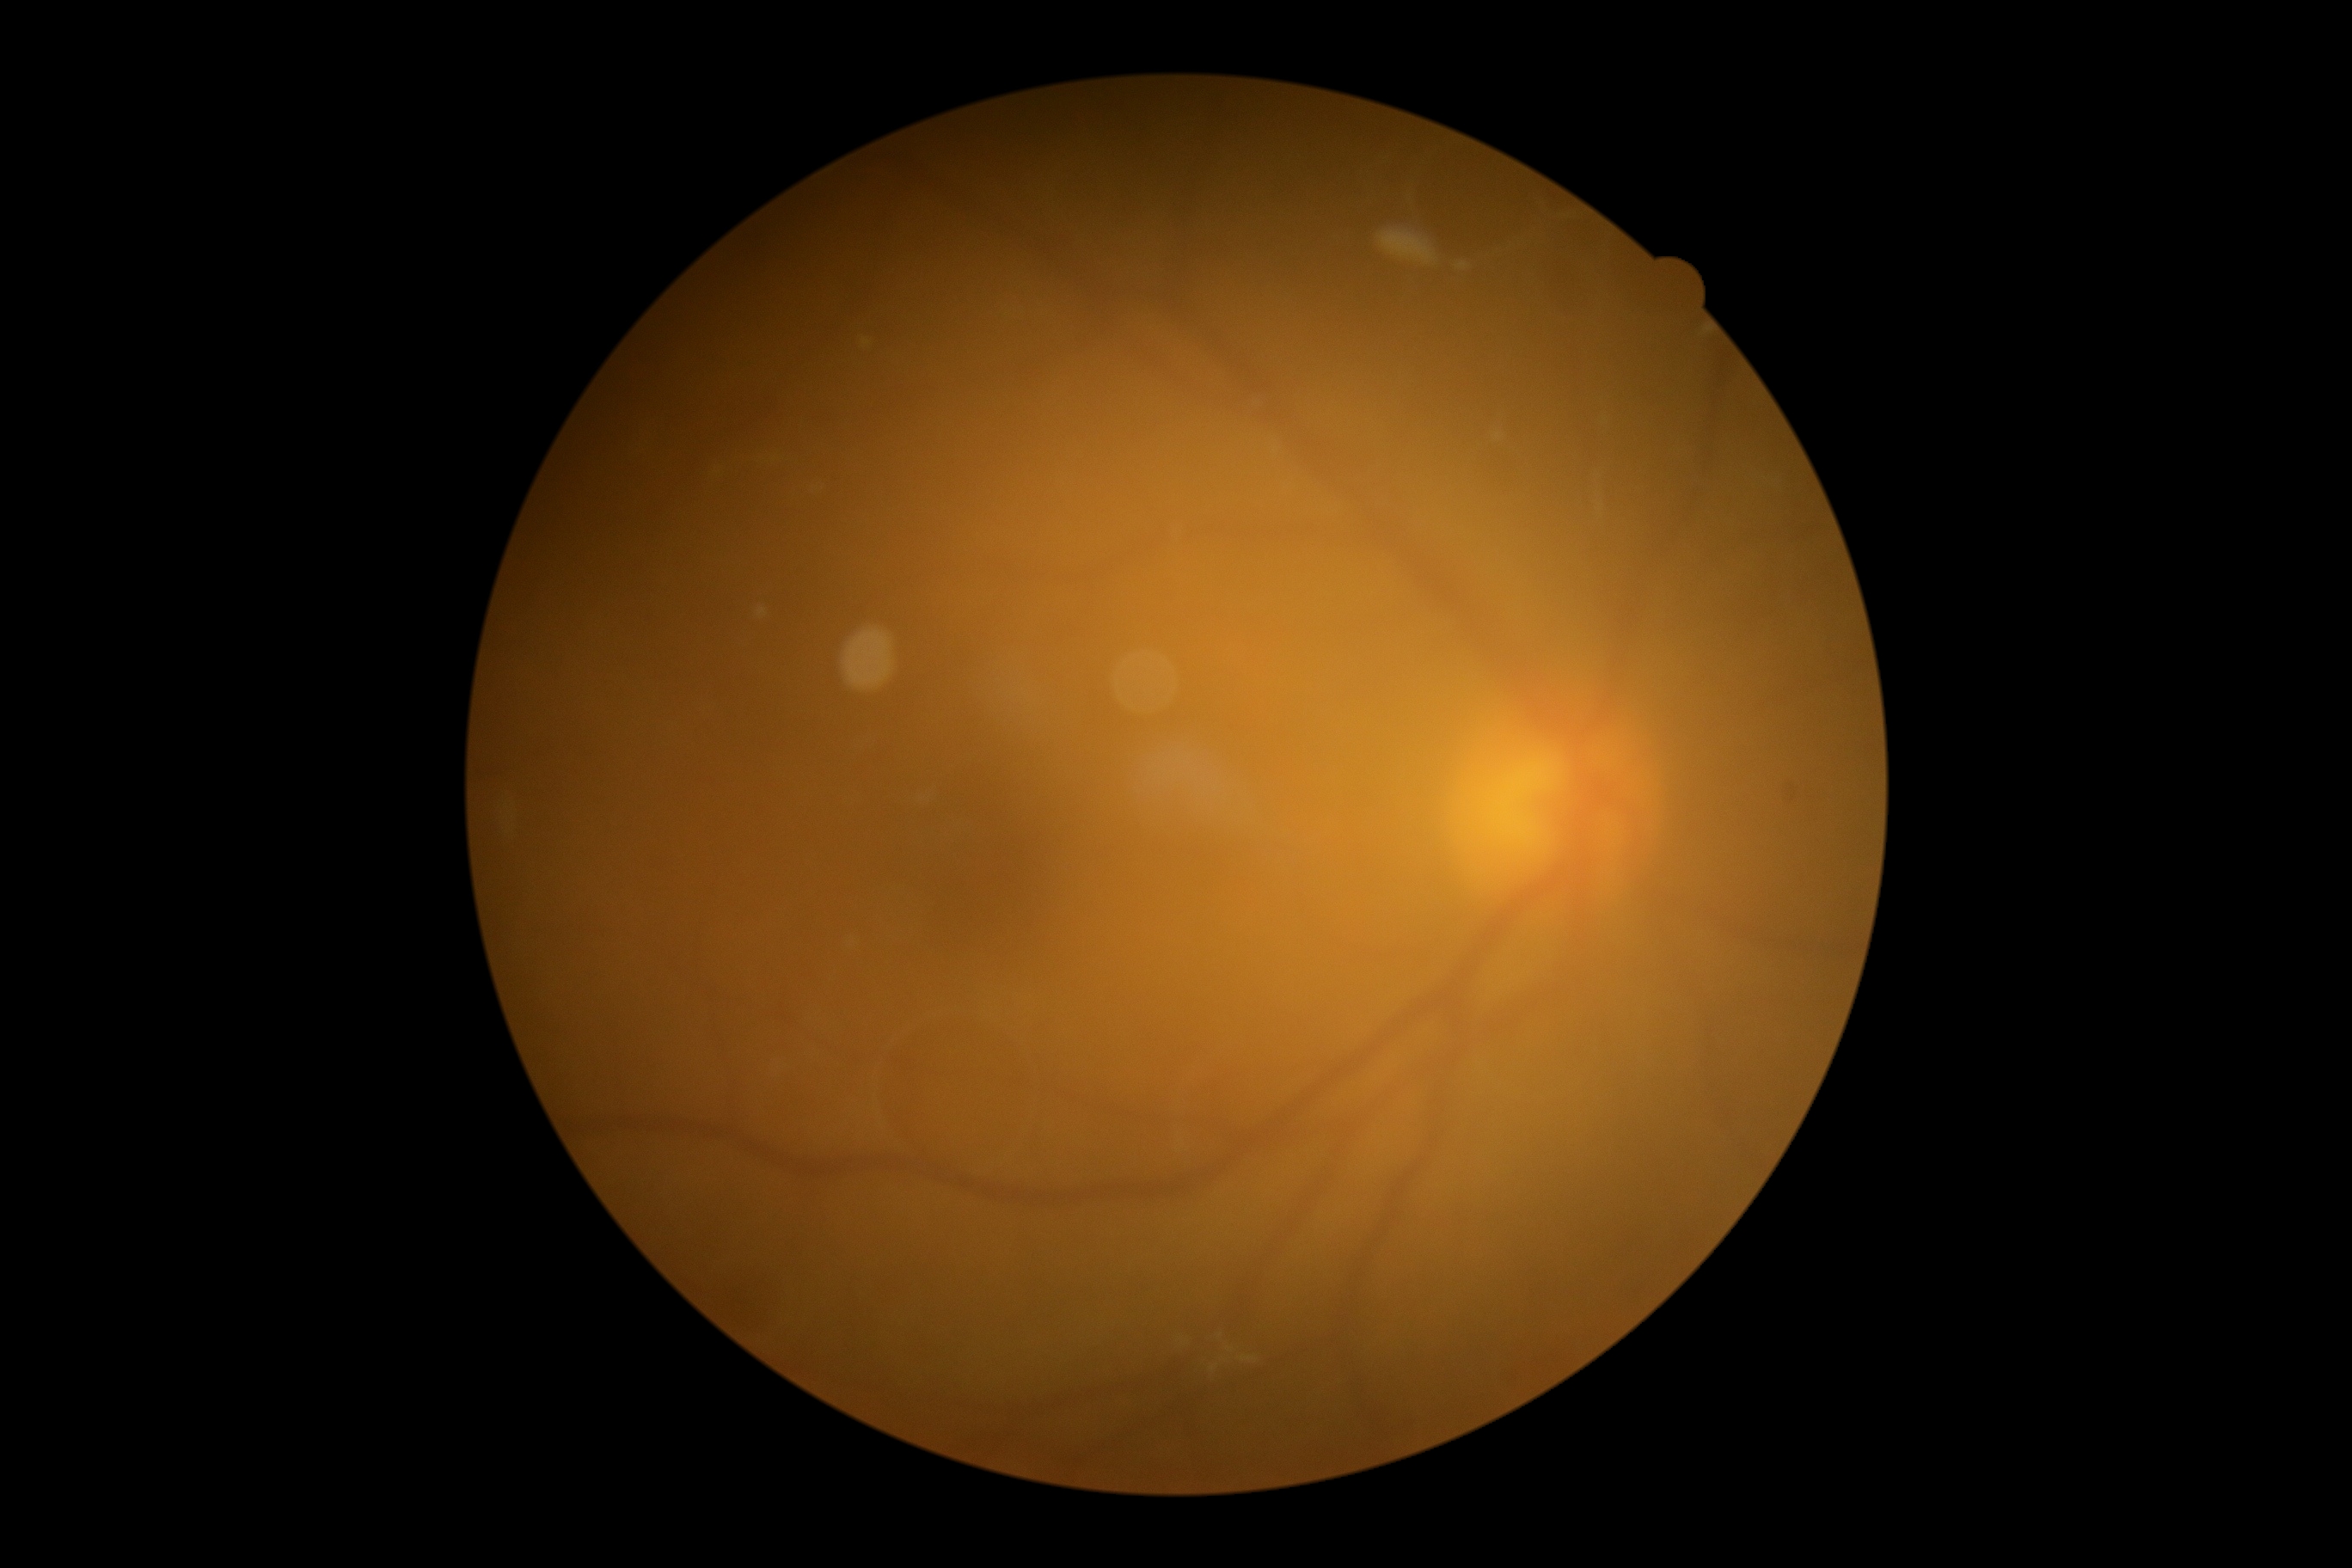

DR severity is grade 0 (no apparent retinopathy).